Camera: NIDEK AFC-230.
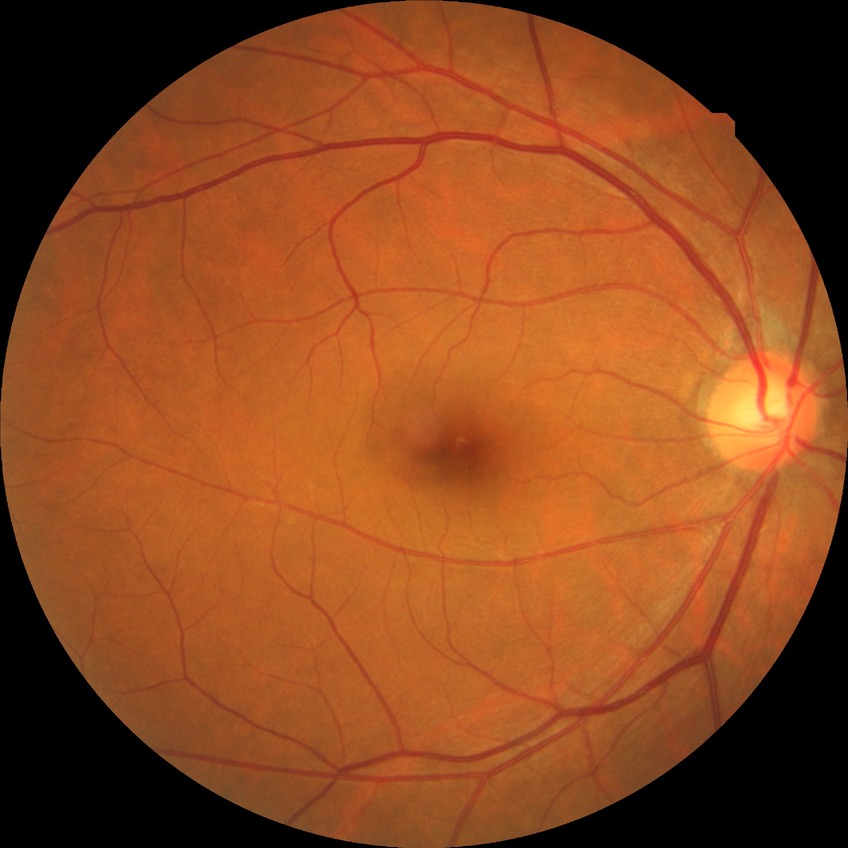 DR grade=SDR.